Wide-field contact fundus photograph of an infant:
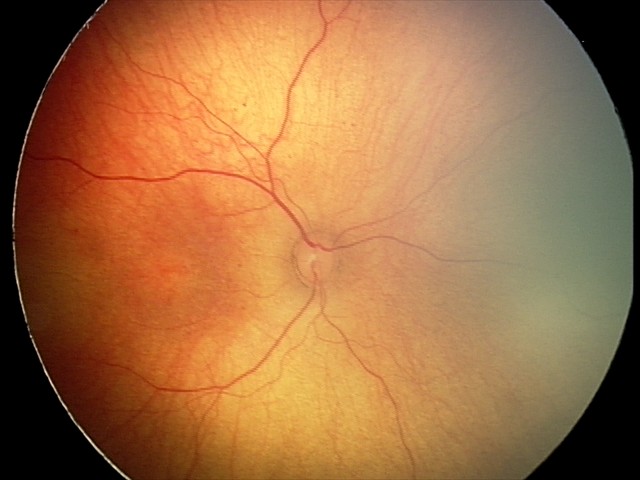 Normal screening examination.